2212x1659, 45-degree field of view.
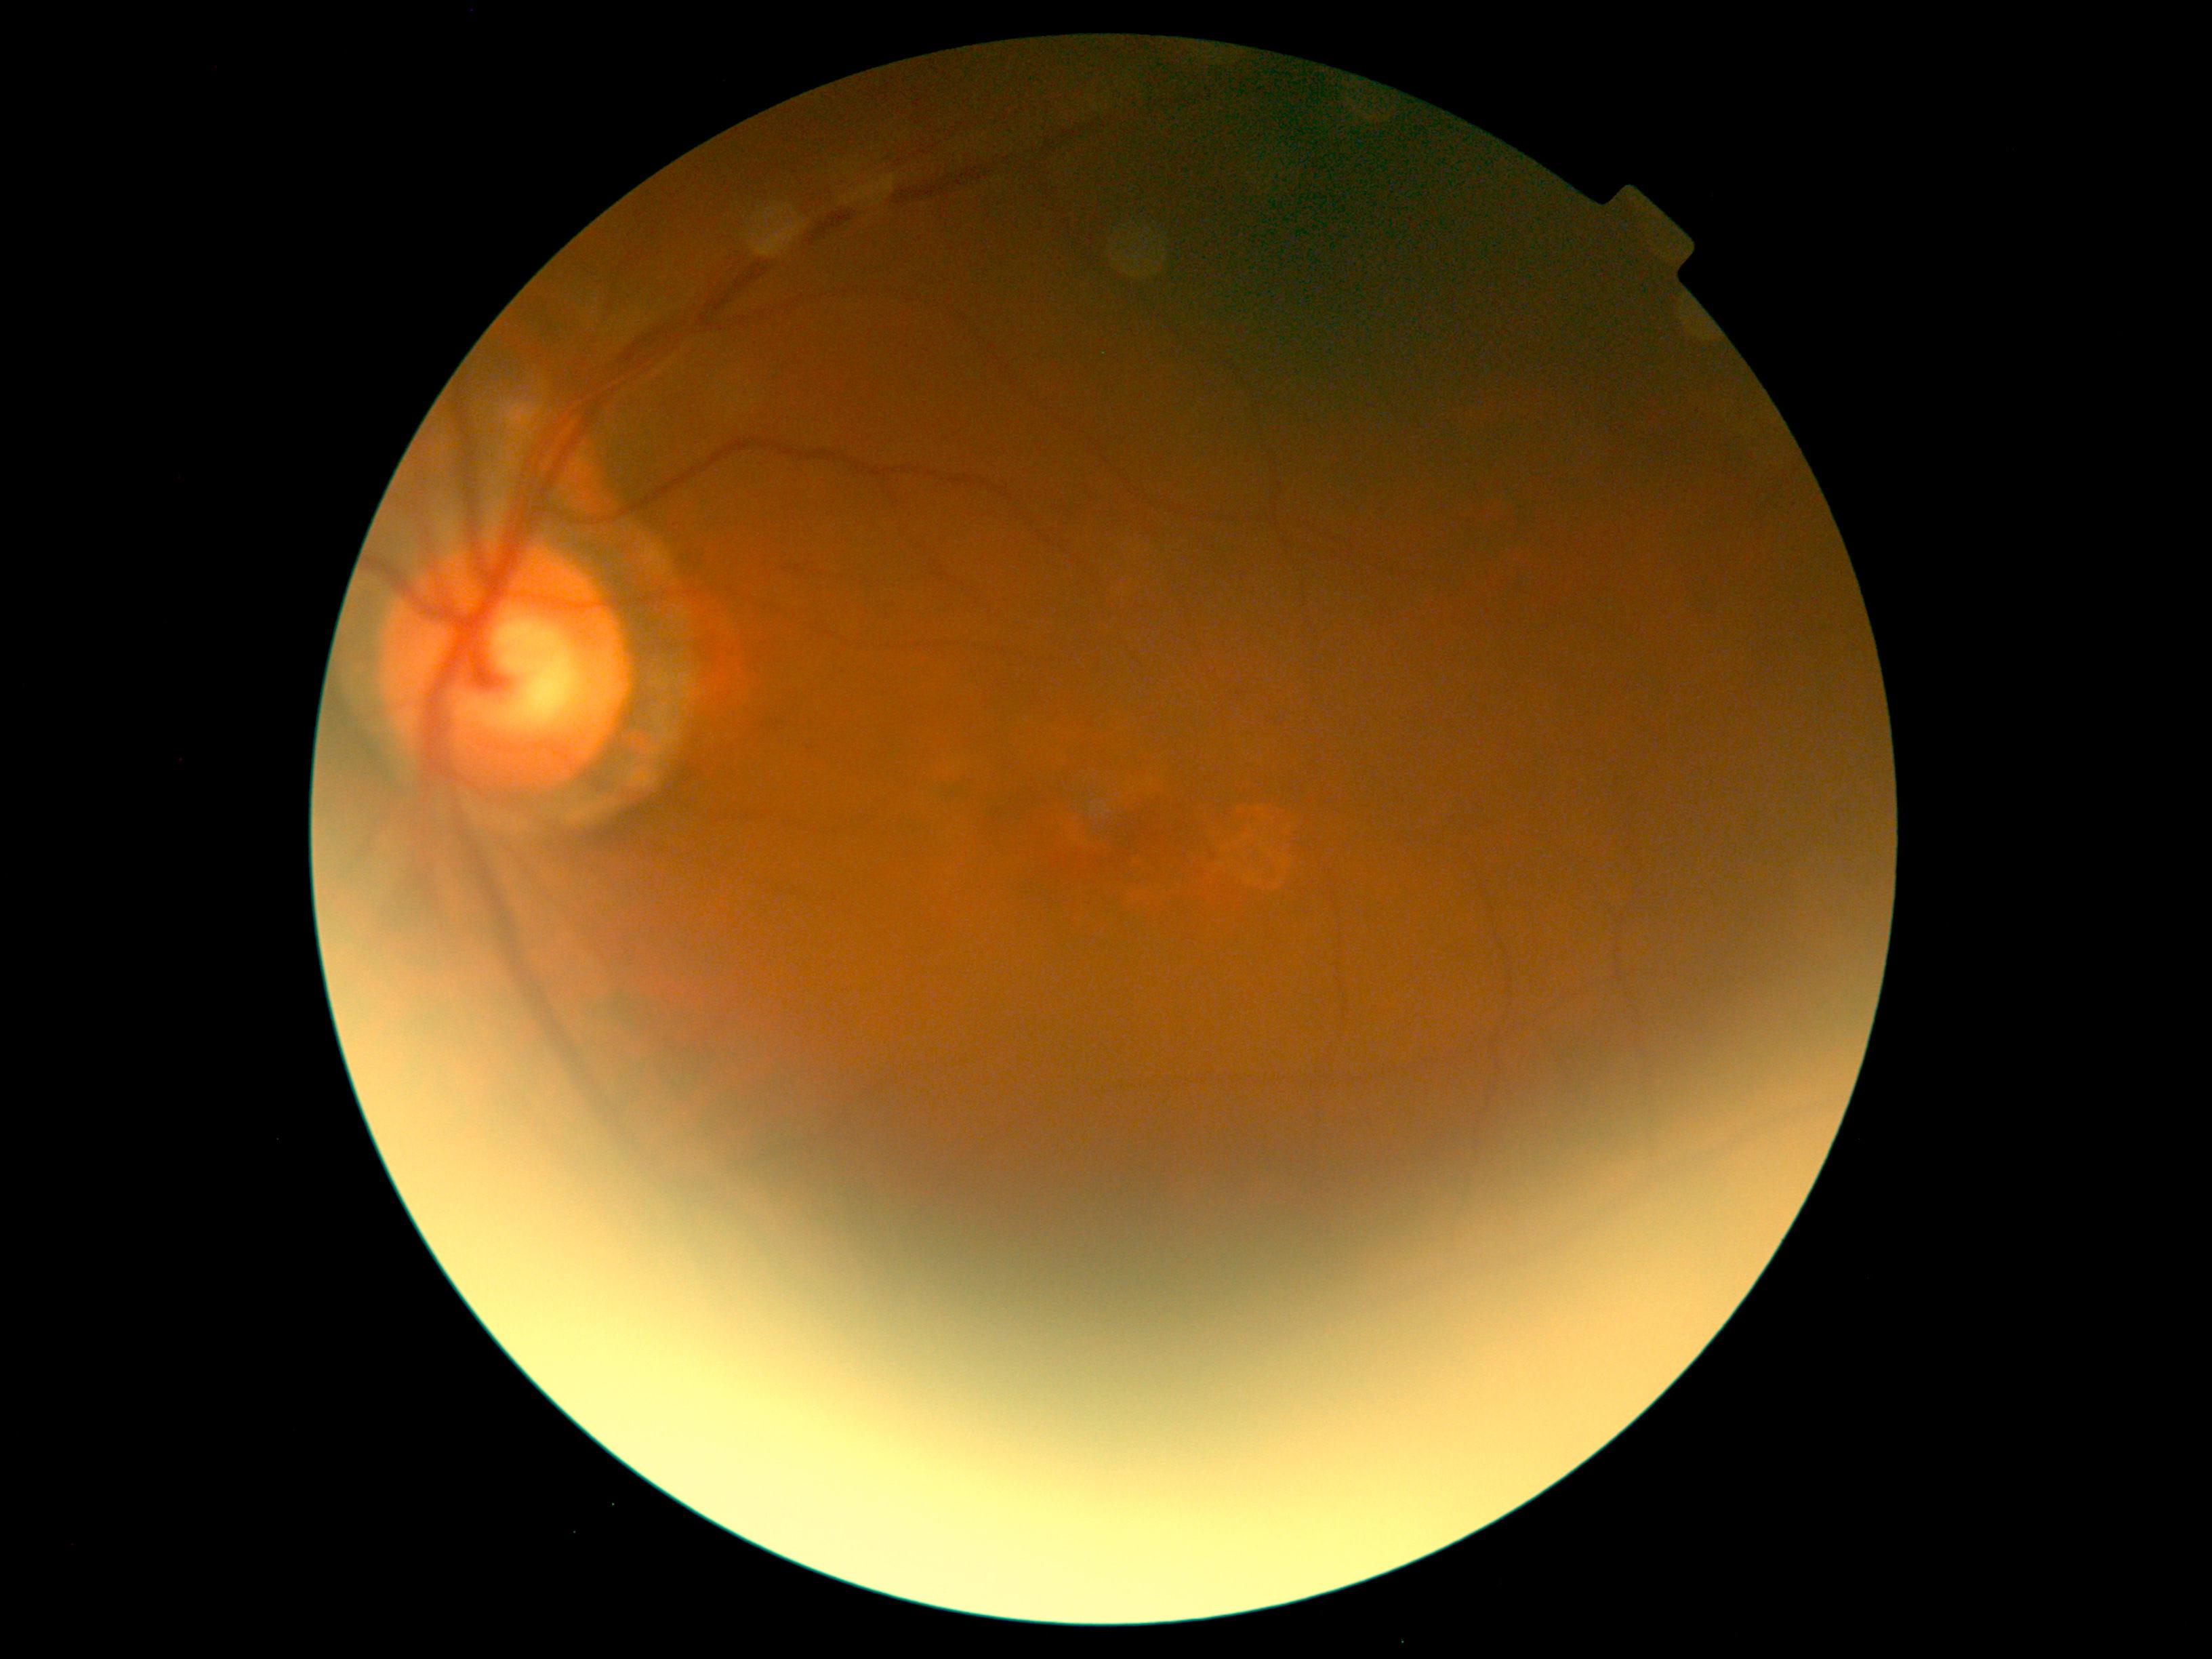

Annotations:
* diabetic retinopathy (DR): no apparent diabetic retinopathy (grade 0)